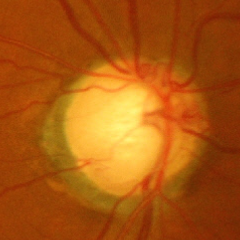

Glaucoma assessment = advanced glaucomatous optic neuropathy.